848x848px, nonmydriatic fundus photograph — 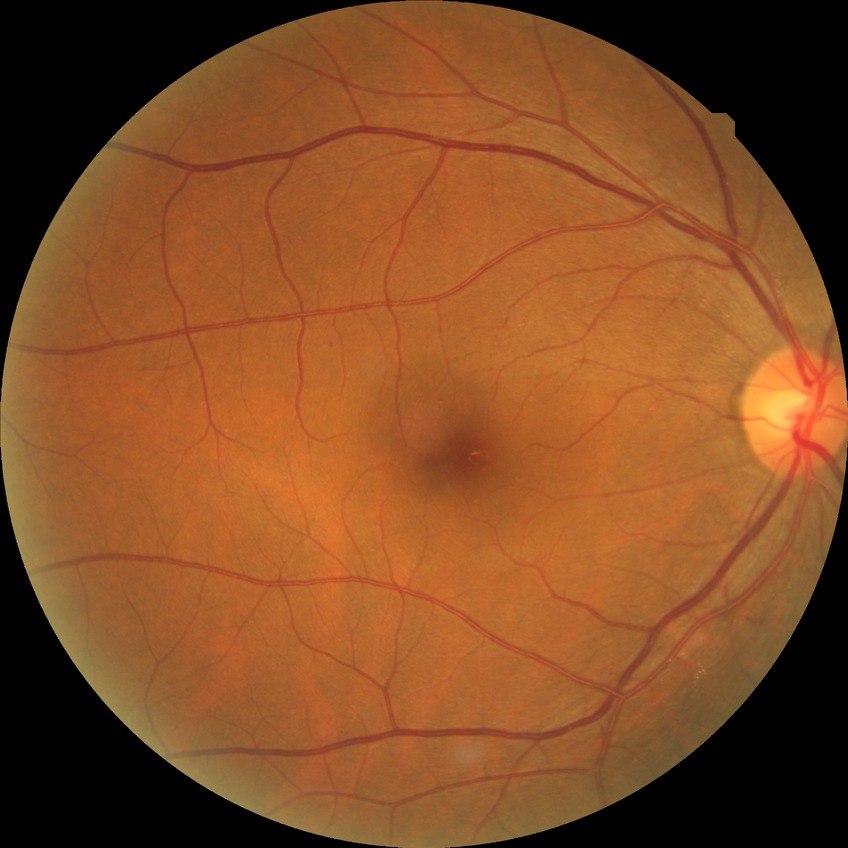

DR class: non-proliferative diabetic retinopathy.
DR stage is SDR.